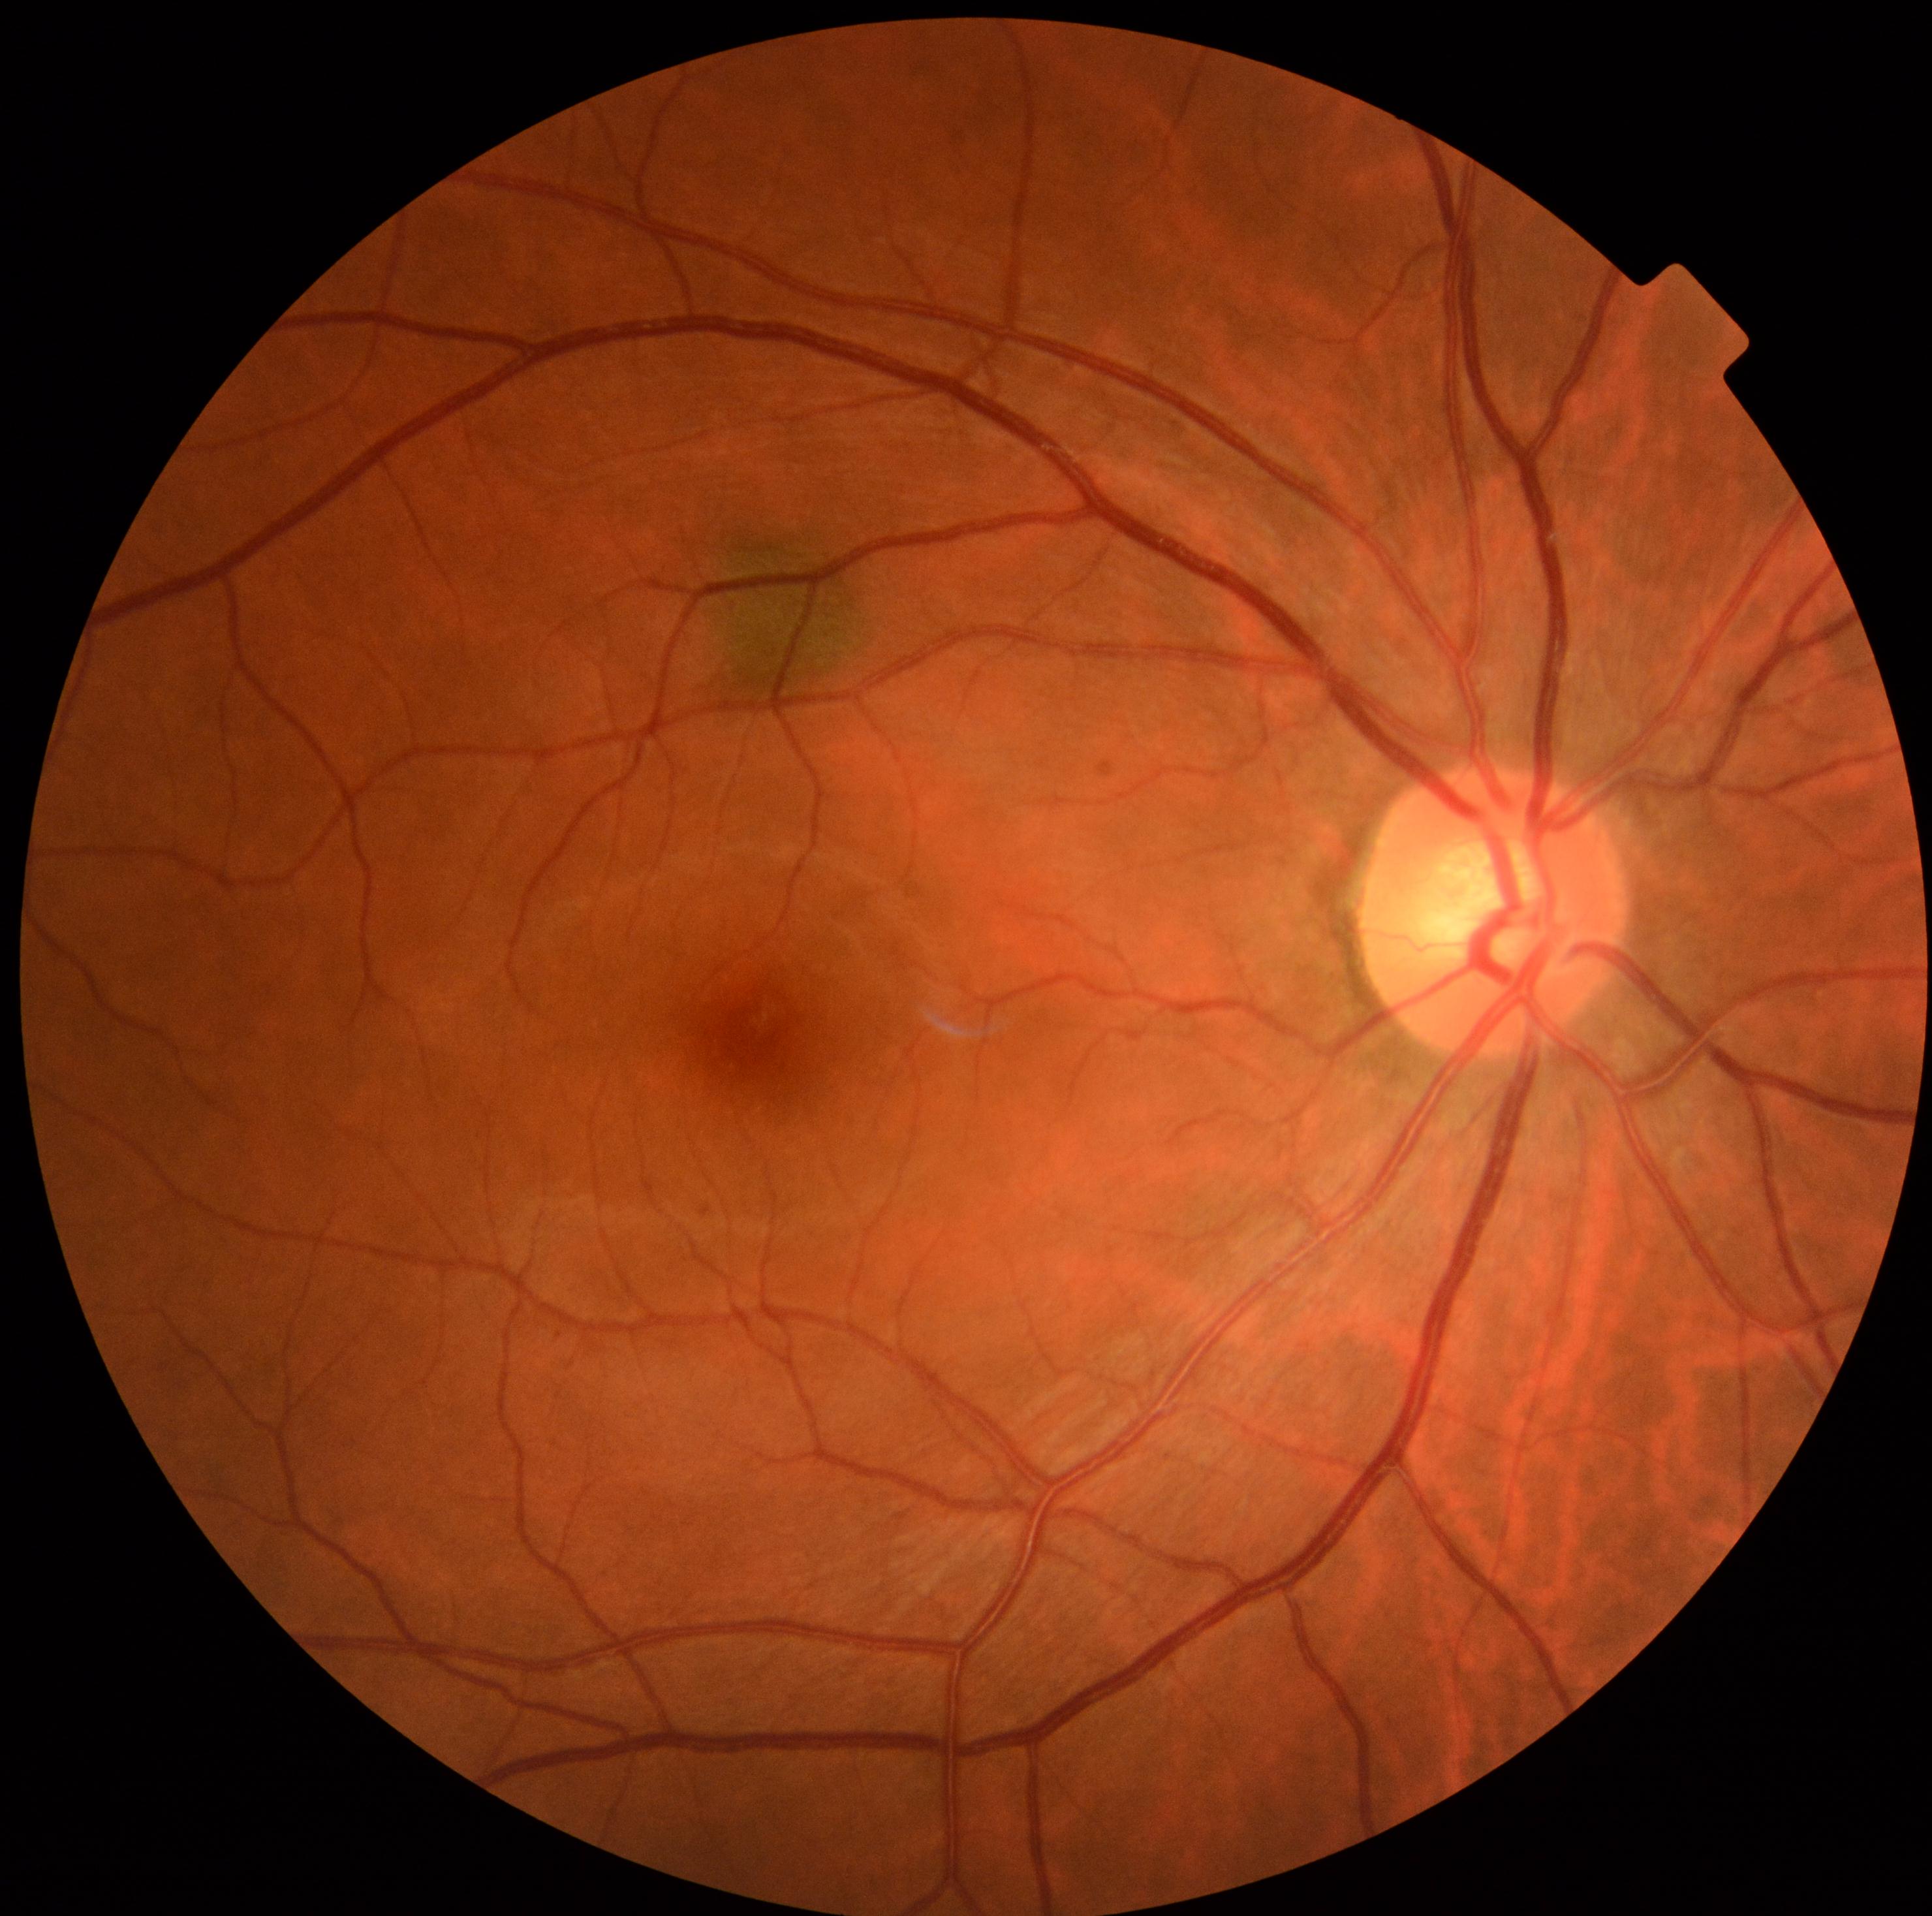

retinopathy grade@1 — presence of microaneurysms only.